Captured with the Phoenix ICON (100° field of view). Infant wide-field fundus photograph
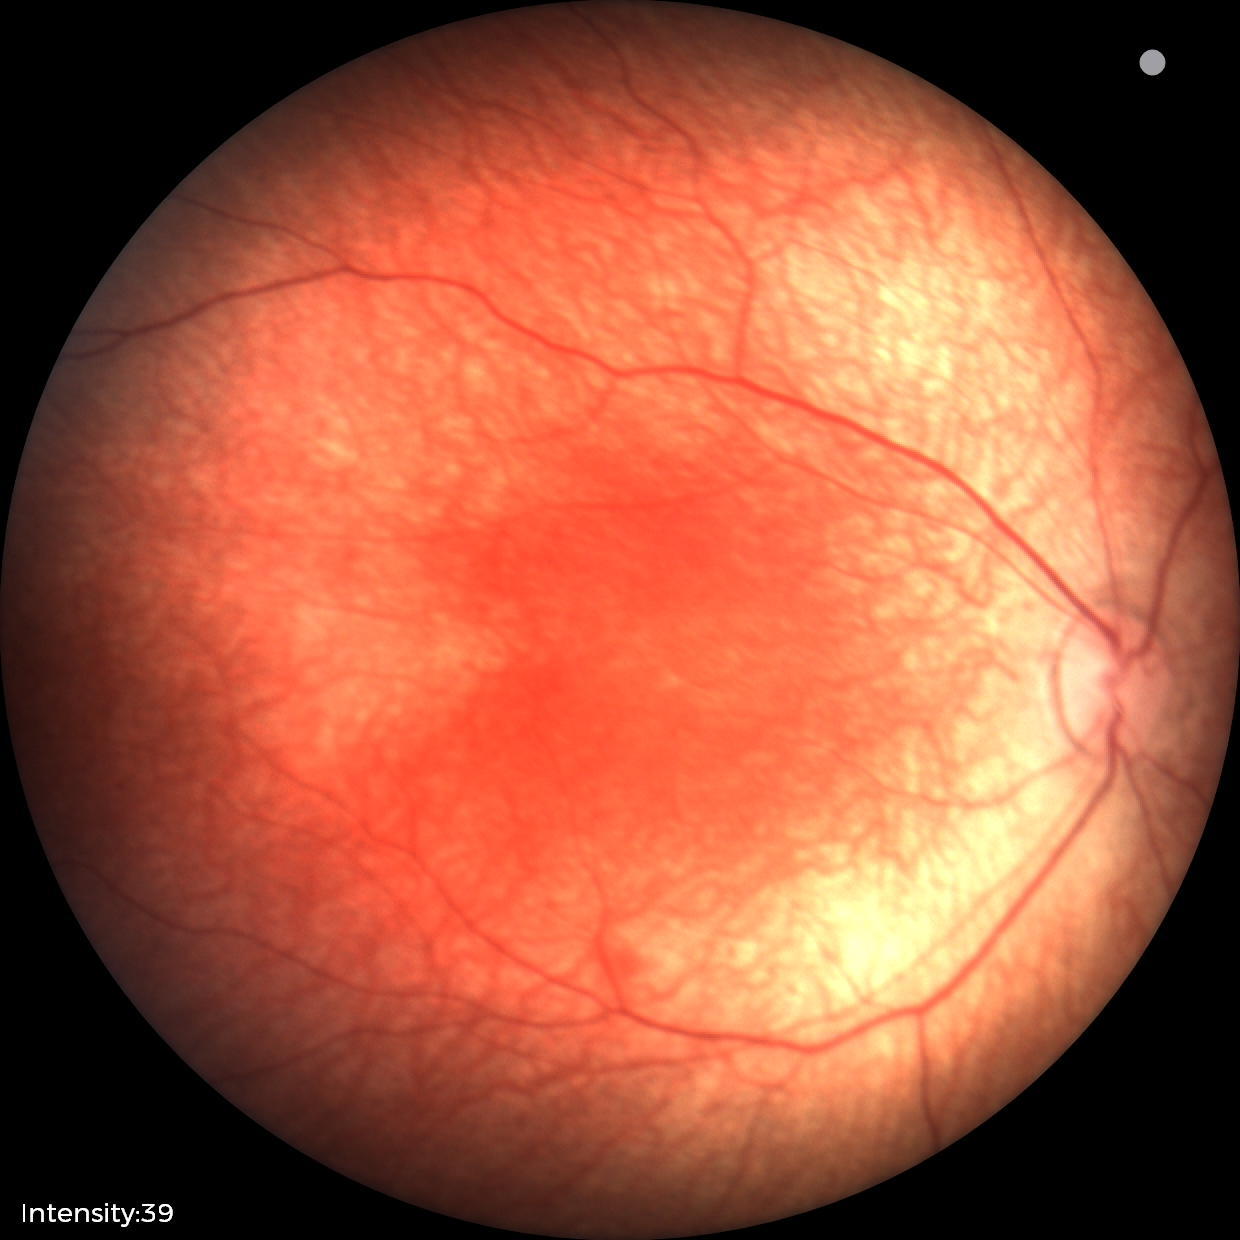

Screening examination with no abnormal retinal findings.